Wide-field fundus image from infant ROP screening:
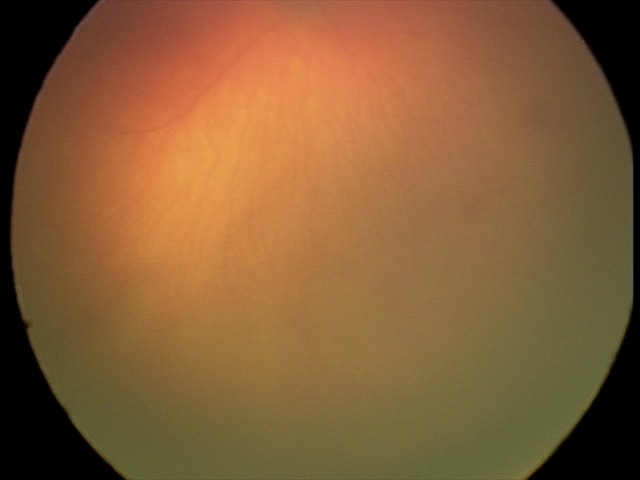 Screening diagnosis: aggressive retinopathy of prematurity — rapidly progressive severe ROP with prominent plus disease, often without classic stage progression.